Camera: NIDEK AFC-230, no pharmacologic dilation: 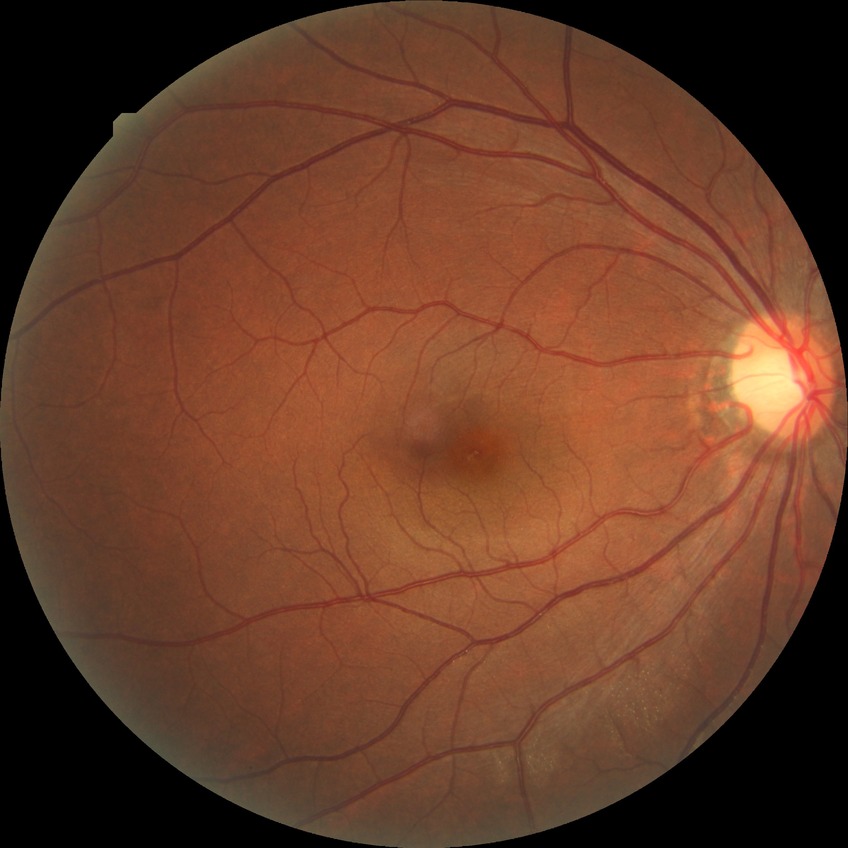
Diabetic retinopathy (DR): no diabetic retinopathy (NDR).